45° field of view. 1932x1932px. Color fundus photograph: 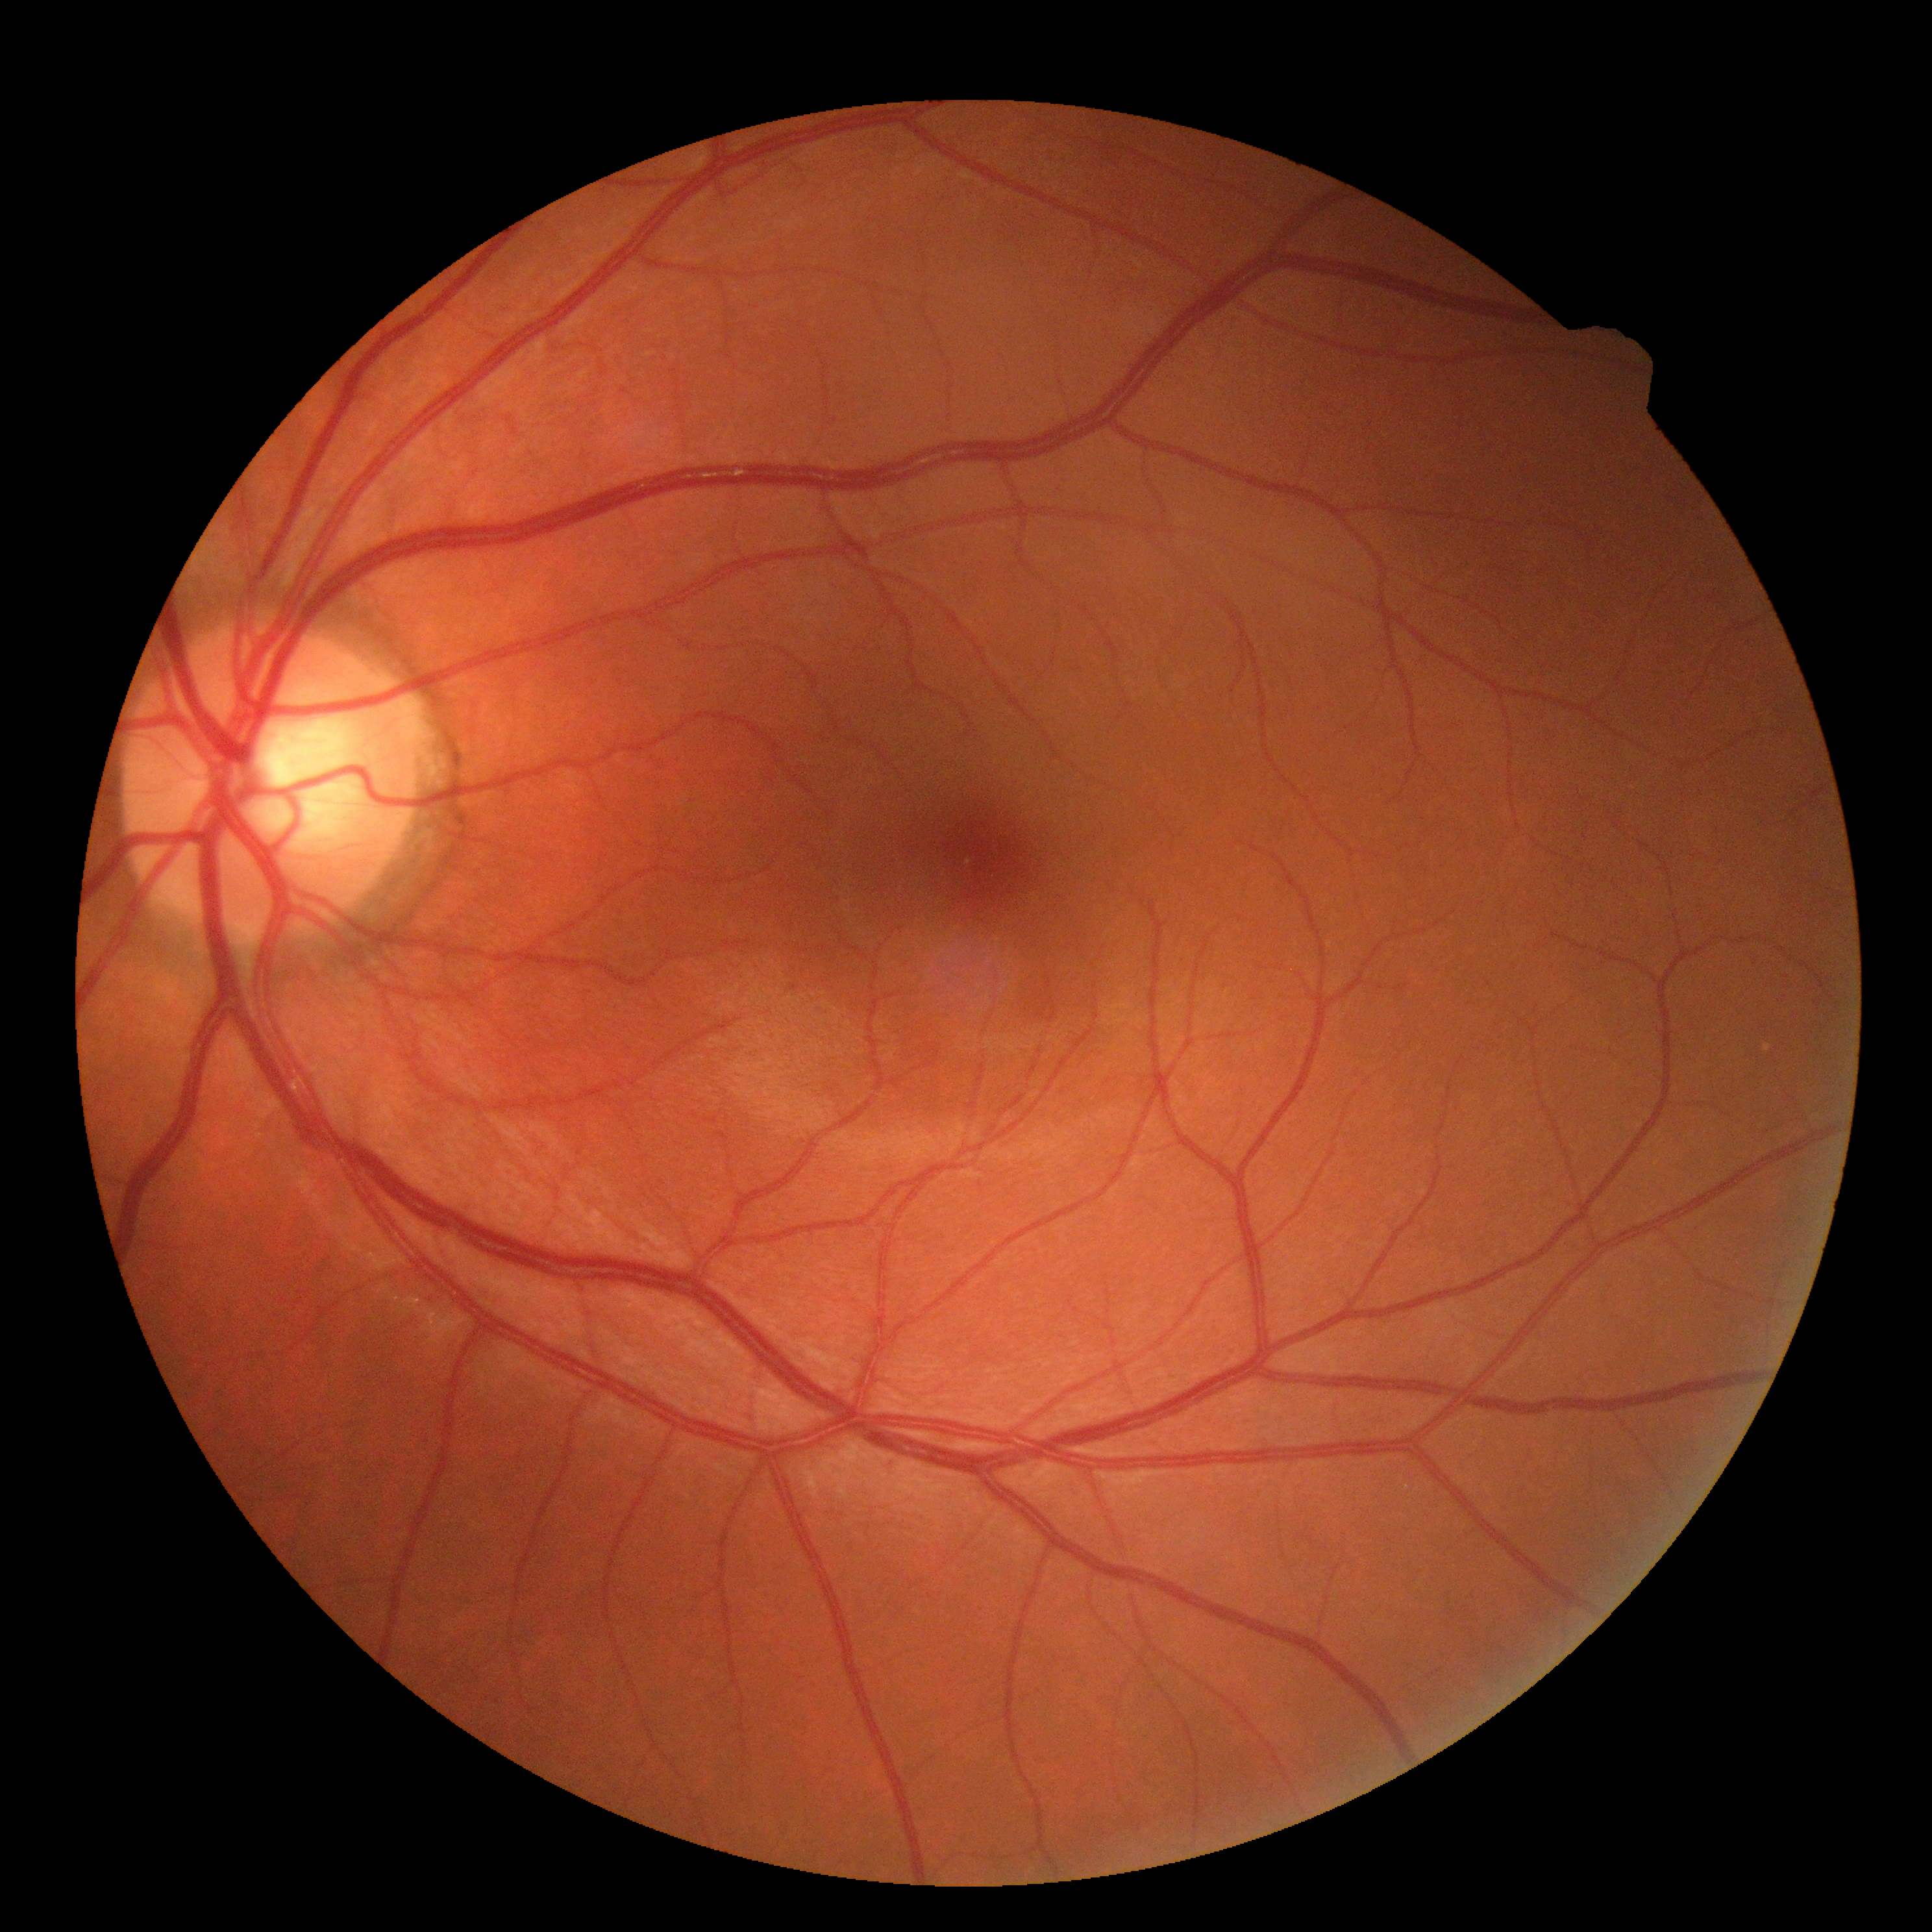

Findings:
* DR impression: no DR findings
* DR severity: grade 0